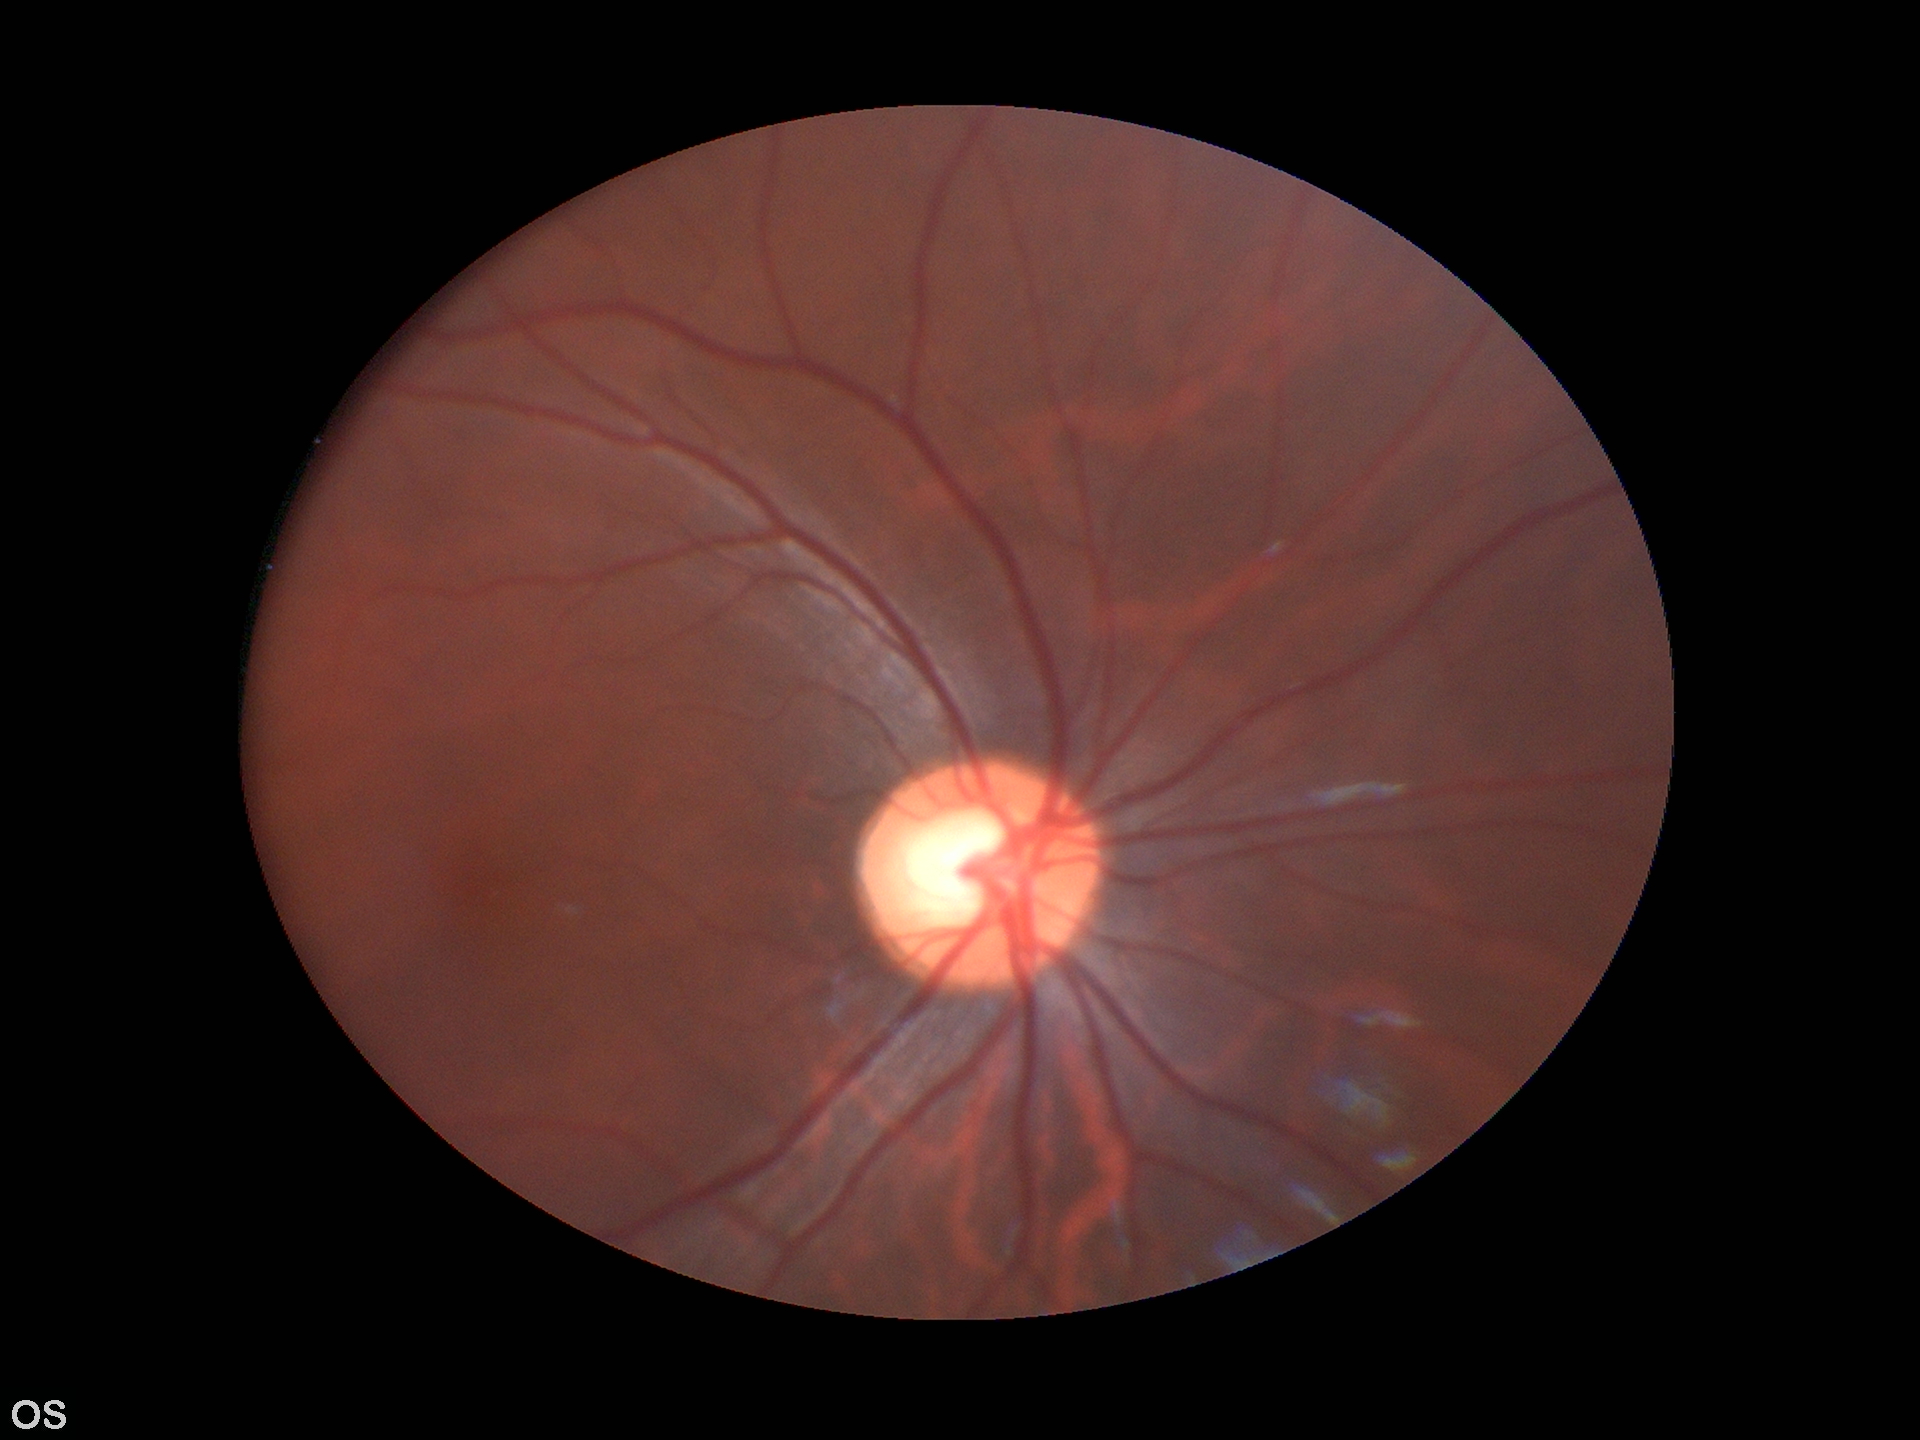
glaucoma_decision: suspicious findings
vcdr: 0.61